FOV: 45 degrees:
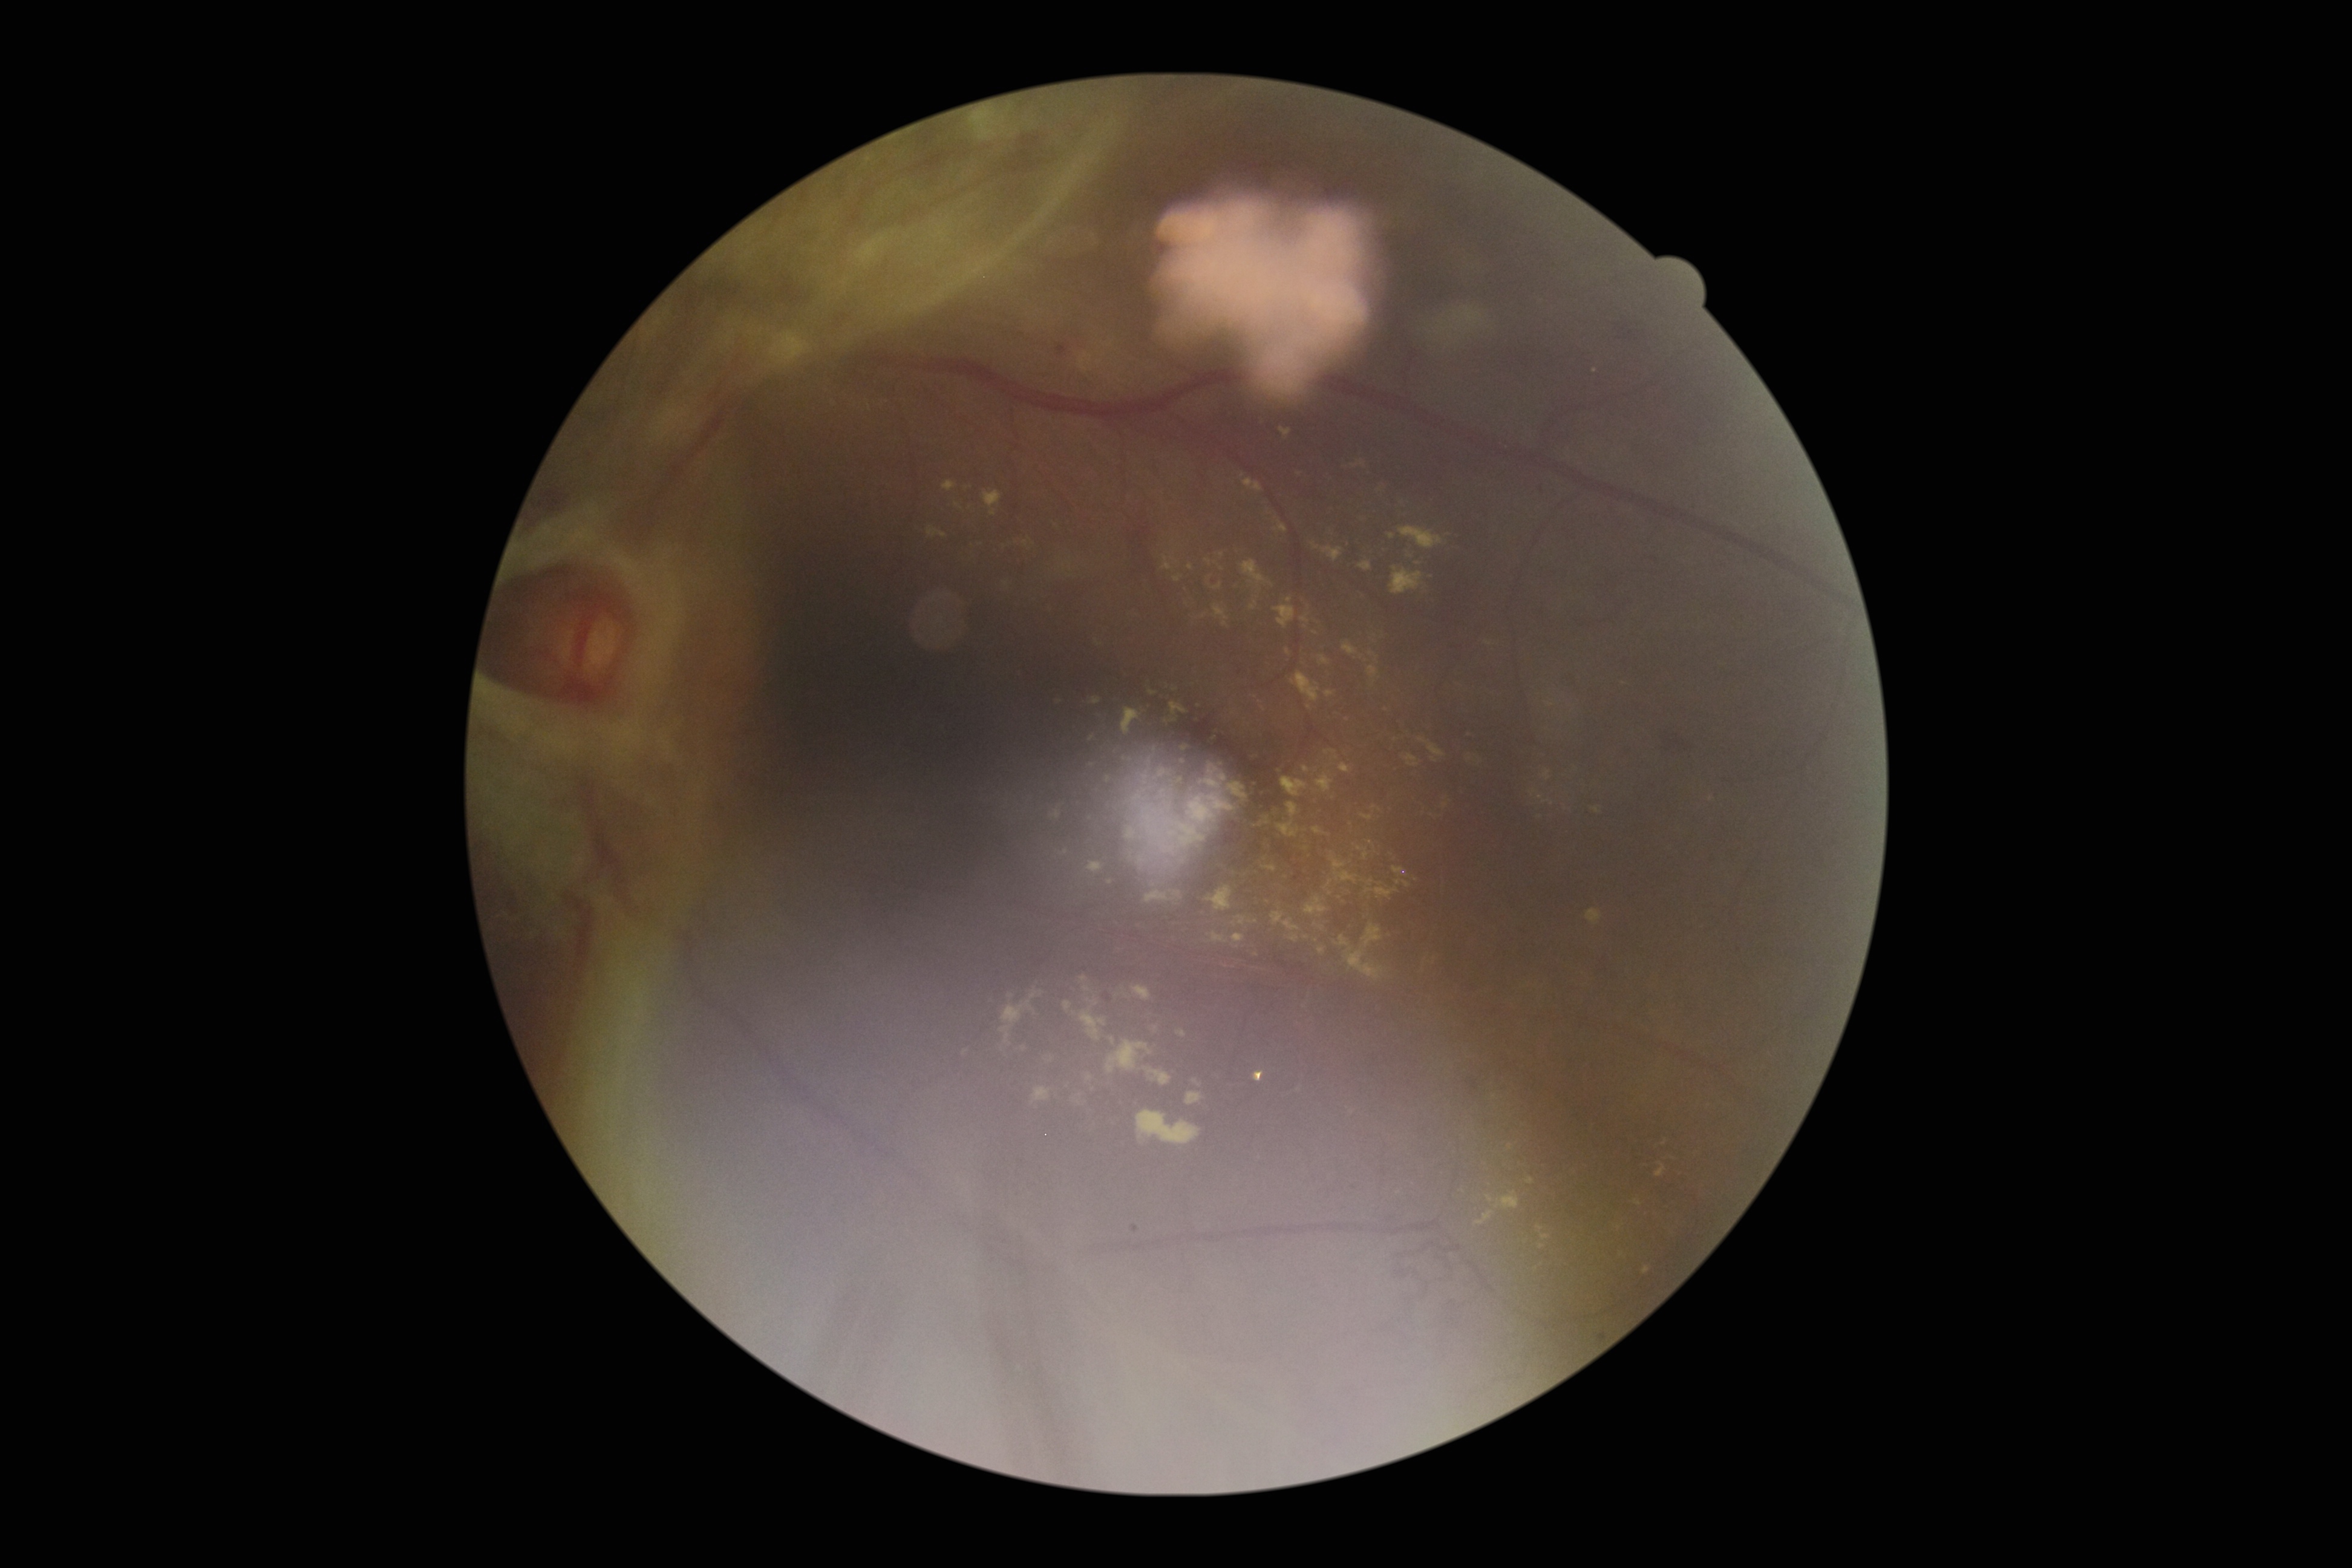

DR stage: grade 4
Selected lesions:
MAs: none
HEs (more not shown): bbox=[1661, 730, 1691, 756] | bbox=[1465, 1074, 1480, 1097] | bbox=[1057, 344, 1067, 356] | bbox=[1613, 320, 1644, 341] | bbox=[1598, 1334, 1606, 1344] | bbox=[1558, 671, 1575, 688] | bbox=[1132, 506, 1158, 579] | bbox=[1535, 482, 1541, 498]
SEs: none
EXs (more not shown): bbox=[1587, 909, 1602, 926] | bbox=[949, 504, 971, 514] | bbox=[983, 491, 1002, 509] | bbox=[1279, 428, 1292, 440] | bbox=[1267, 900, 1283, 912] | bbox=[1179, 764, 1253, 844] | bbox=[1007, 539, 1029, 554] | bbox=[1102, 774, 1112, 783] | bbox=[1346, 821, 1353, 838] | bbox=[1082, 734, 1088, 748] | bbox=[1241, 474, 1263, 493] | bbox=[1174, 575, 1181, 583] | bbox=[1149, 887, 1185, 907] | bbox=[1261, 815, 1304, 841] | bbox=[1273, 607, 1296, 630]
Additional small EXs near (1480,762) | (1539,1229) | (1307,935)